Nonmydriatic fundus photograph.
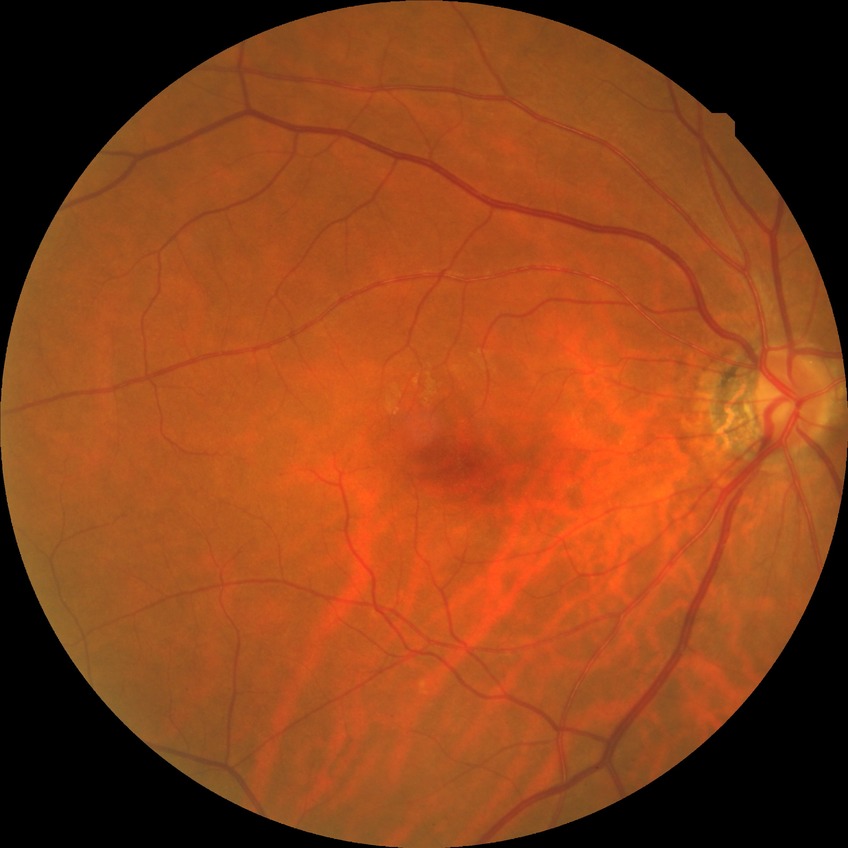

diabetic retinopathy severity: no diabetic retinopathy.